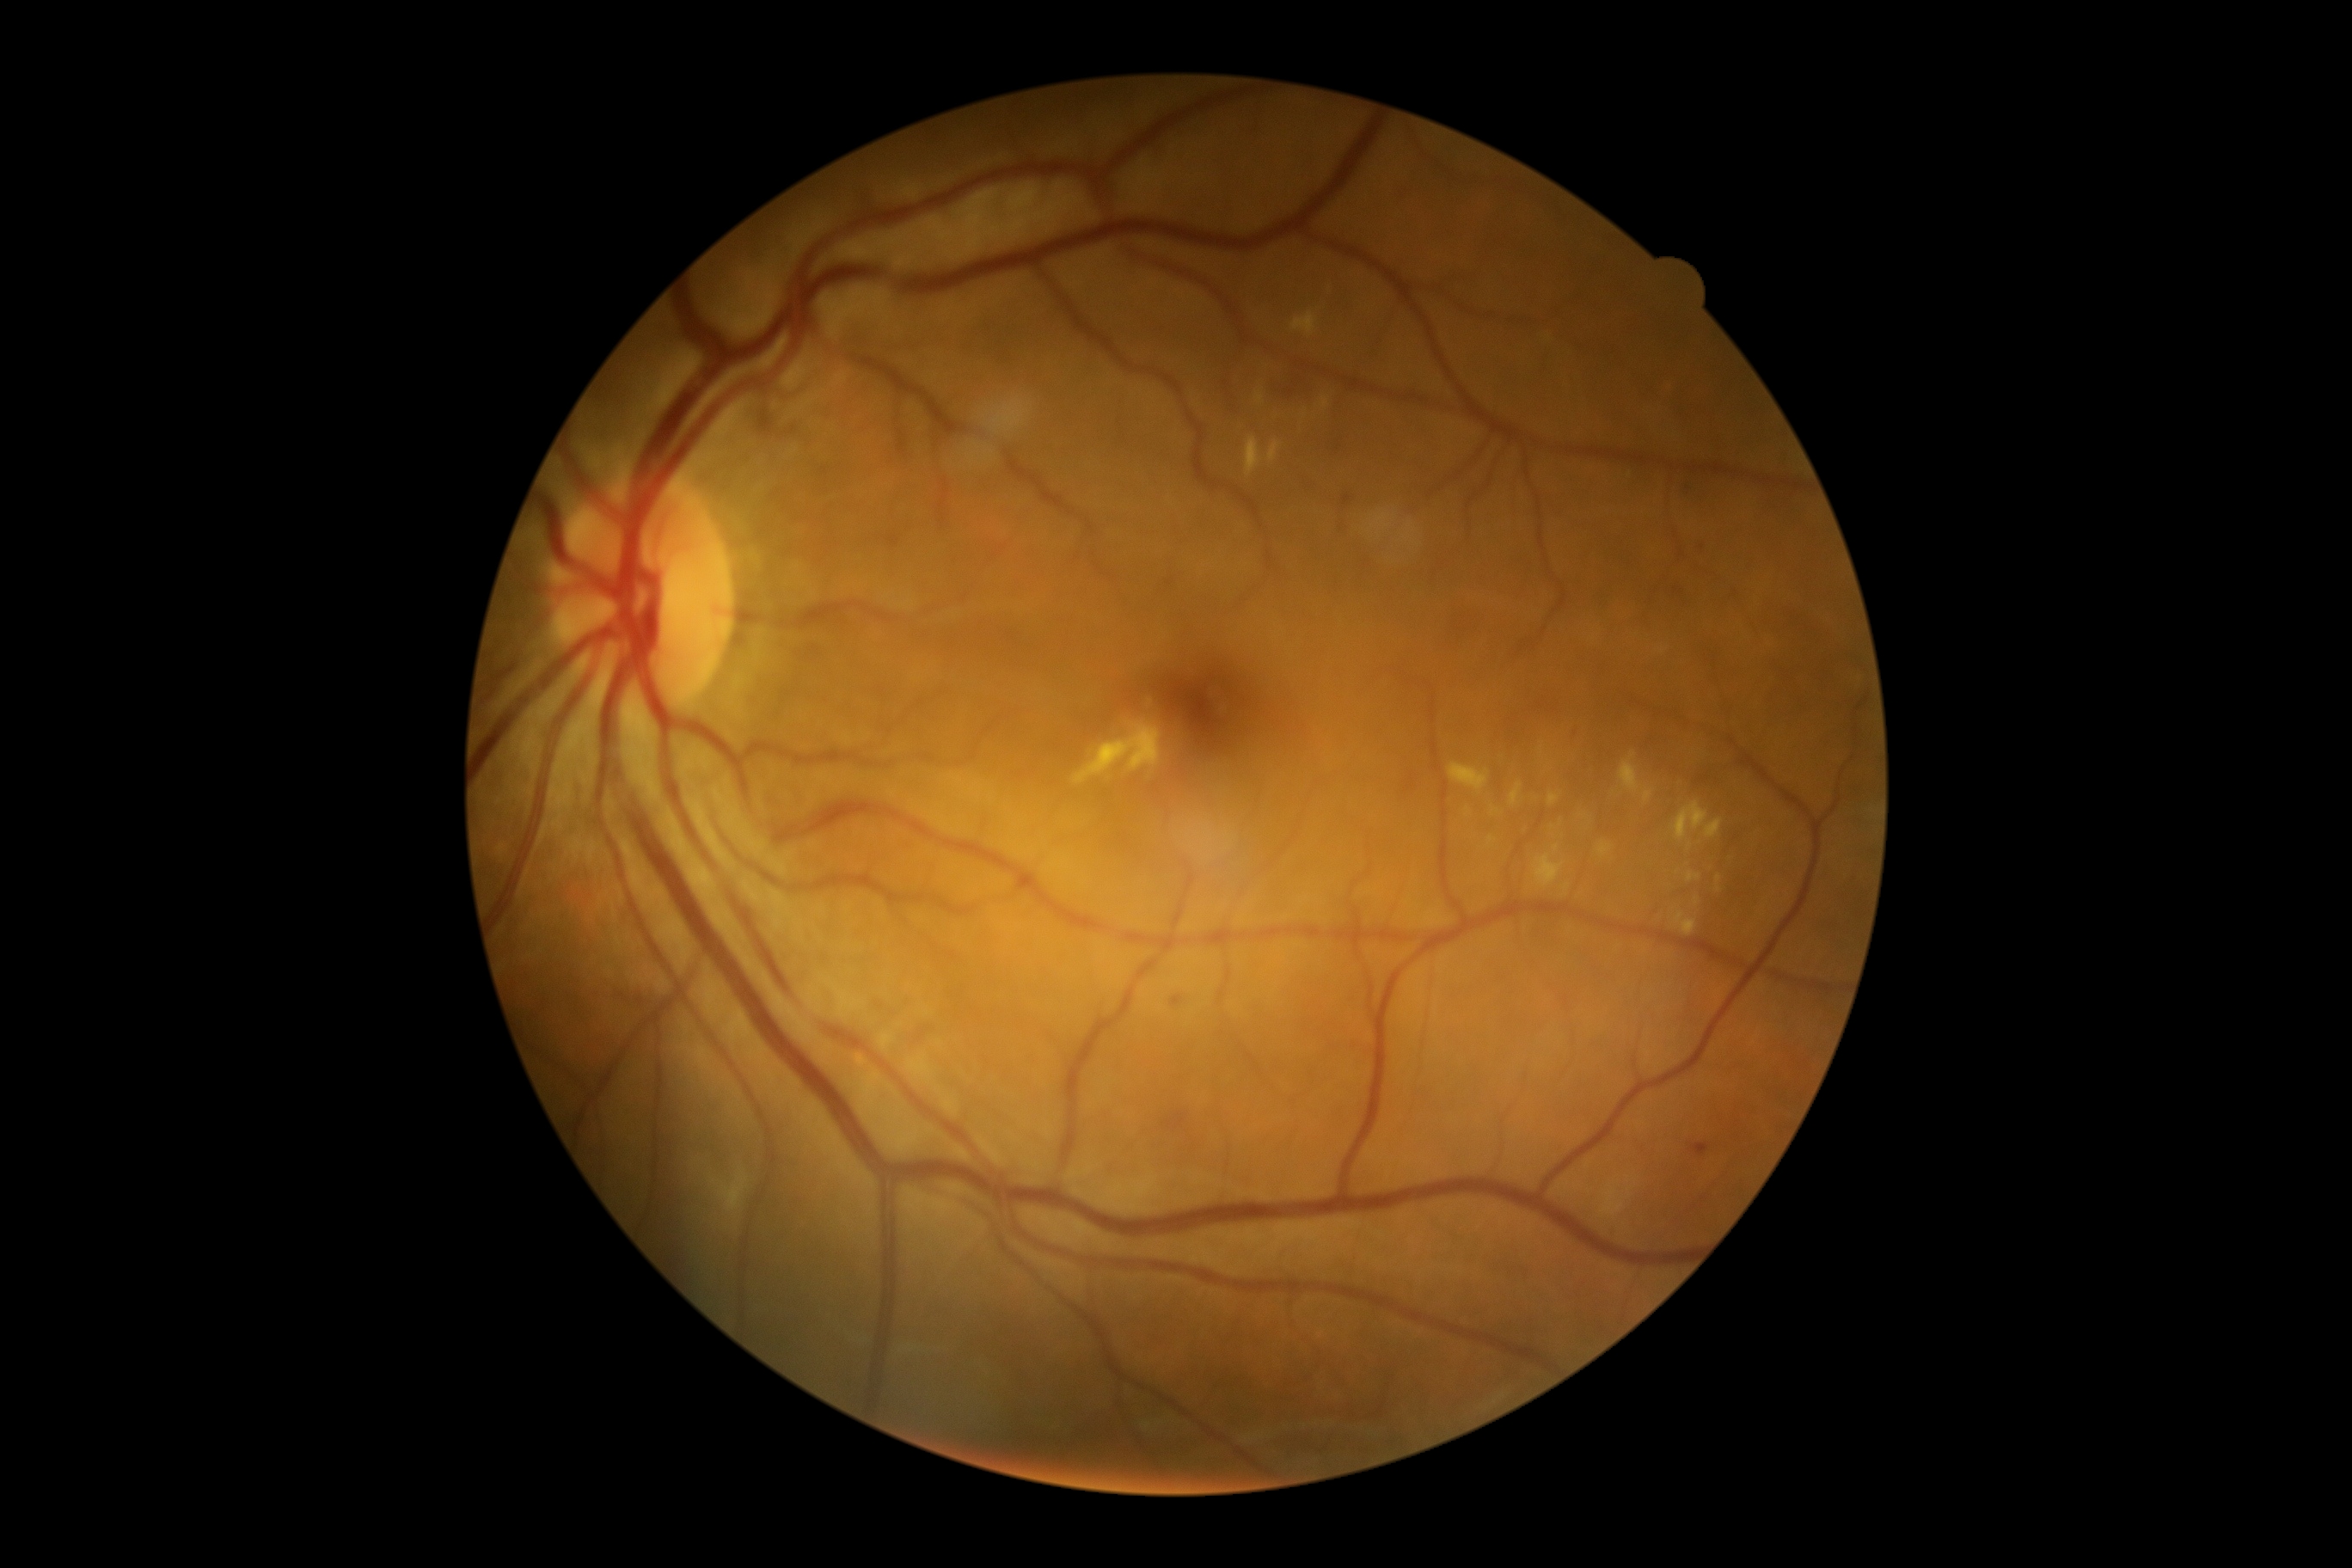

{"partial": true, "dr_grade": 2, "dr_grade_name": "moderate NPDR", "lesions": {"ex": [[1674, 802, 1724, 842], [1321, 396, 1330, 410], [1619, 754, 1639, 793], [1510, 783, 1522, 807], [1687, 871, 1701, 883], [1717, 874, 1722, 883], [1553, 845, 1559, 854], [1268, 441, 1280, 462], [1449, 764, 1490, 795], [1292, 312, 1318, 336]], "ex_small_approx": [[1567, 887], [1468, 811]]}}